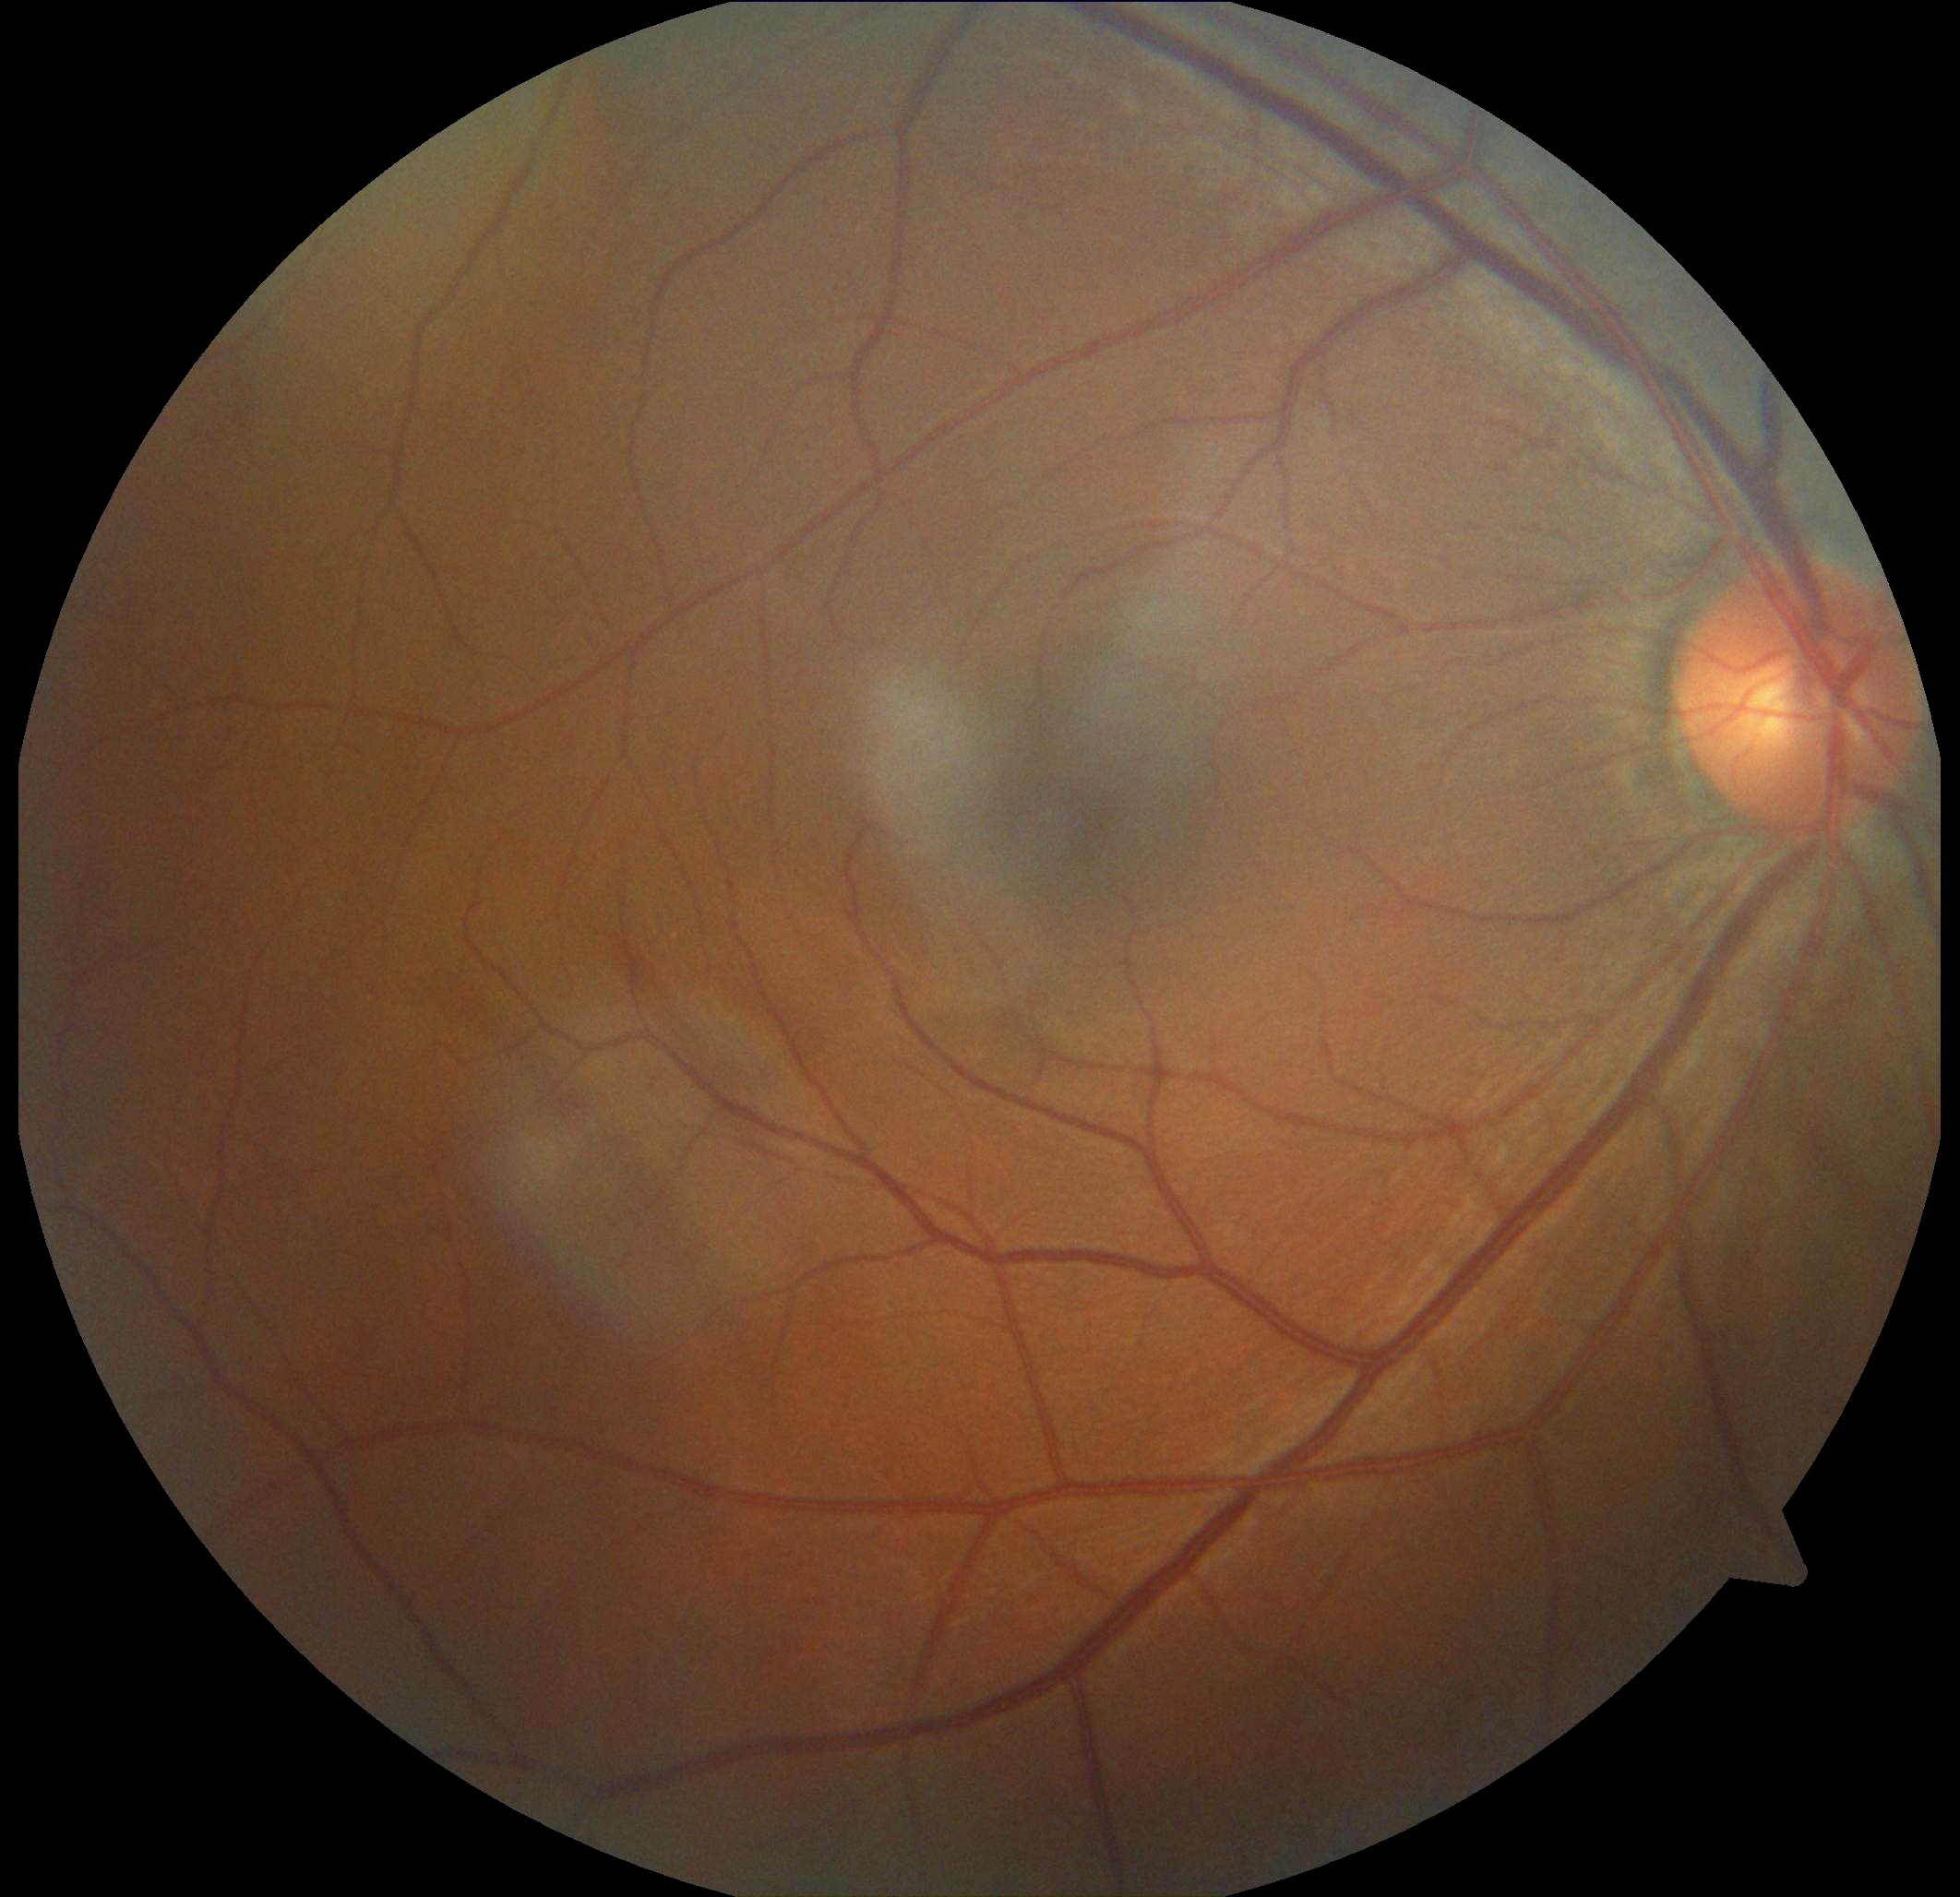

Diabetic retinopathy grade: 0.